Image size 640x480 · pediatric retinal photograph (wide-field) · acquired on the Clarity RetCam 3 — 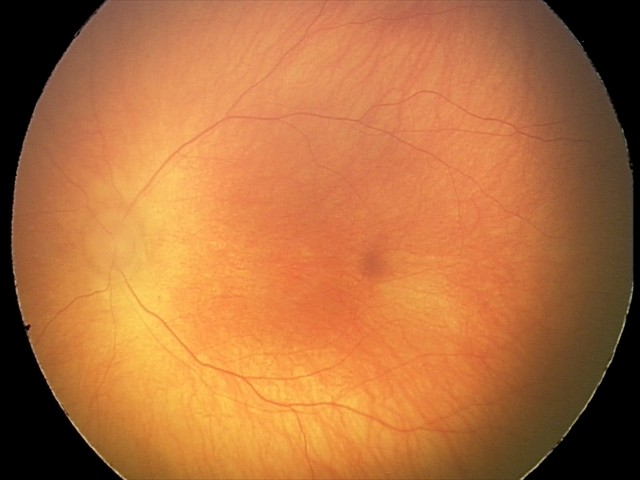
Q: What is the diagnosis from this examination?
A: ROP stage 0
Q: Is plus disease present?
A: no plus disease